45-degree field of view — 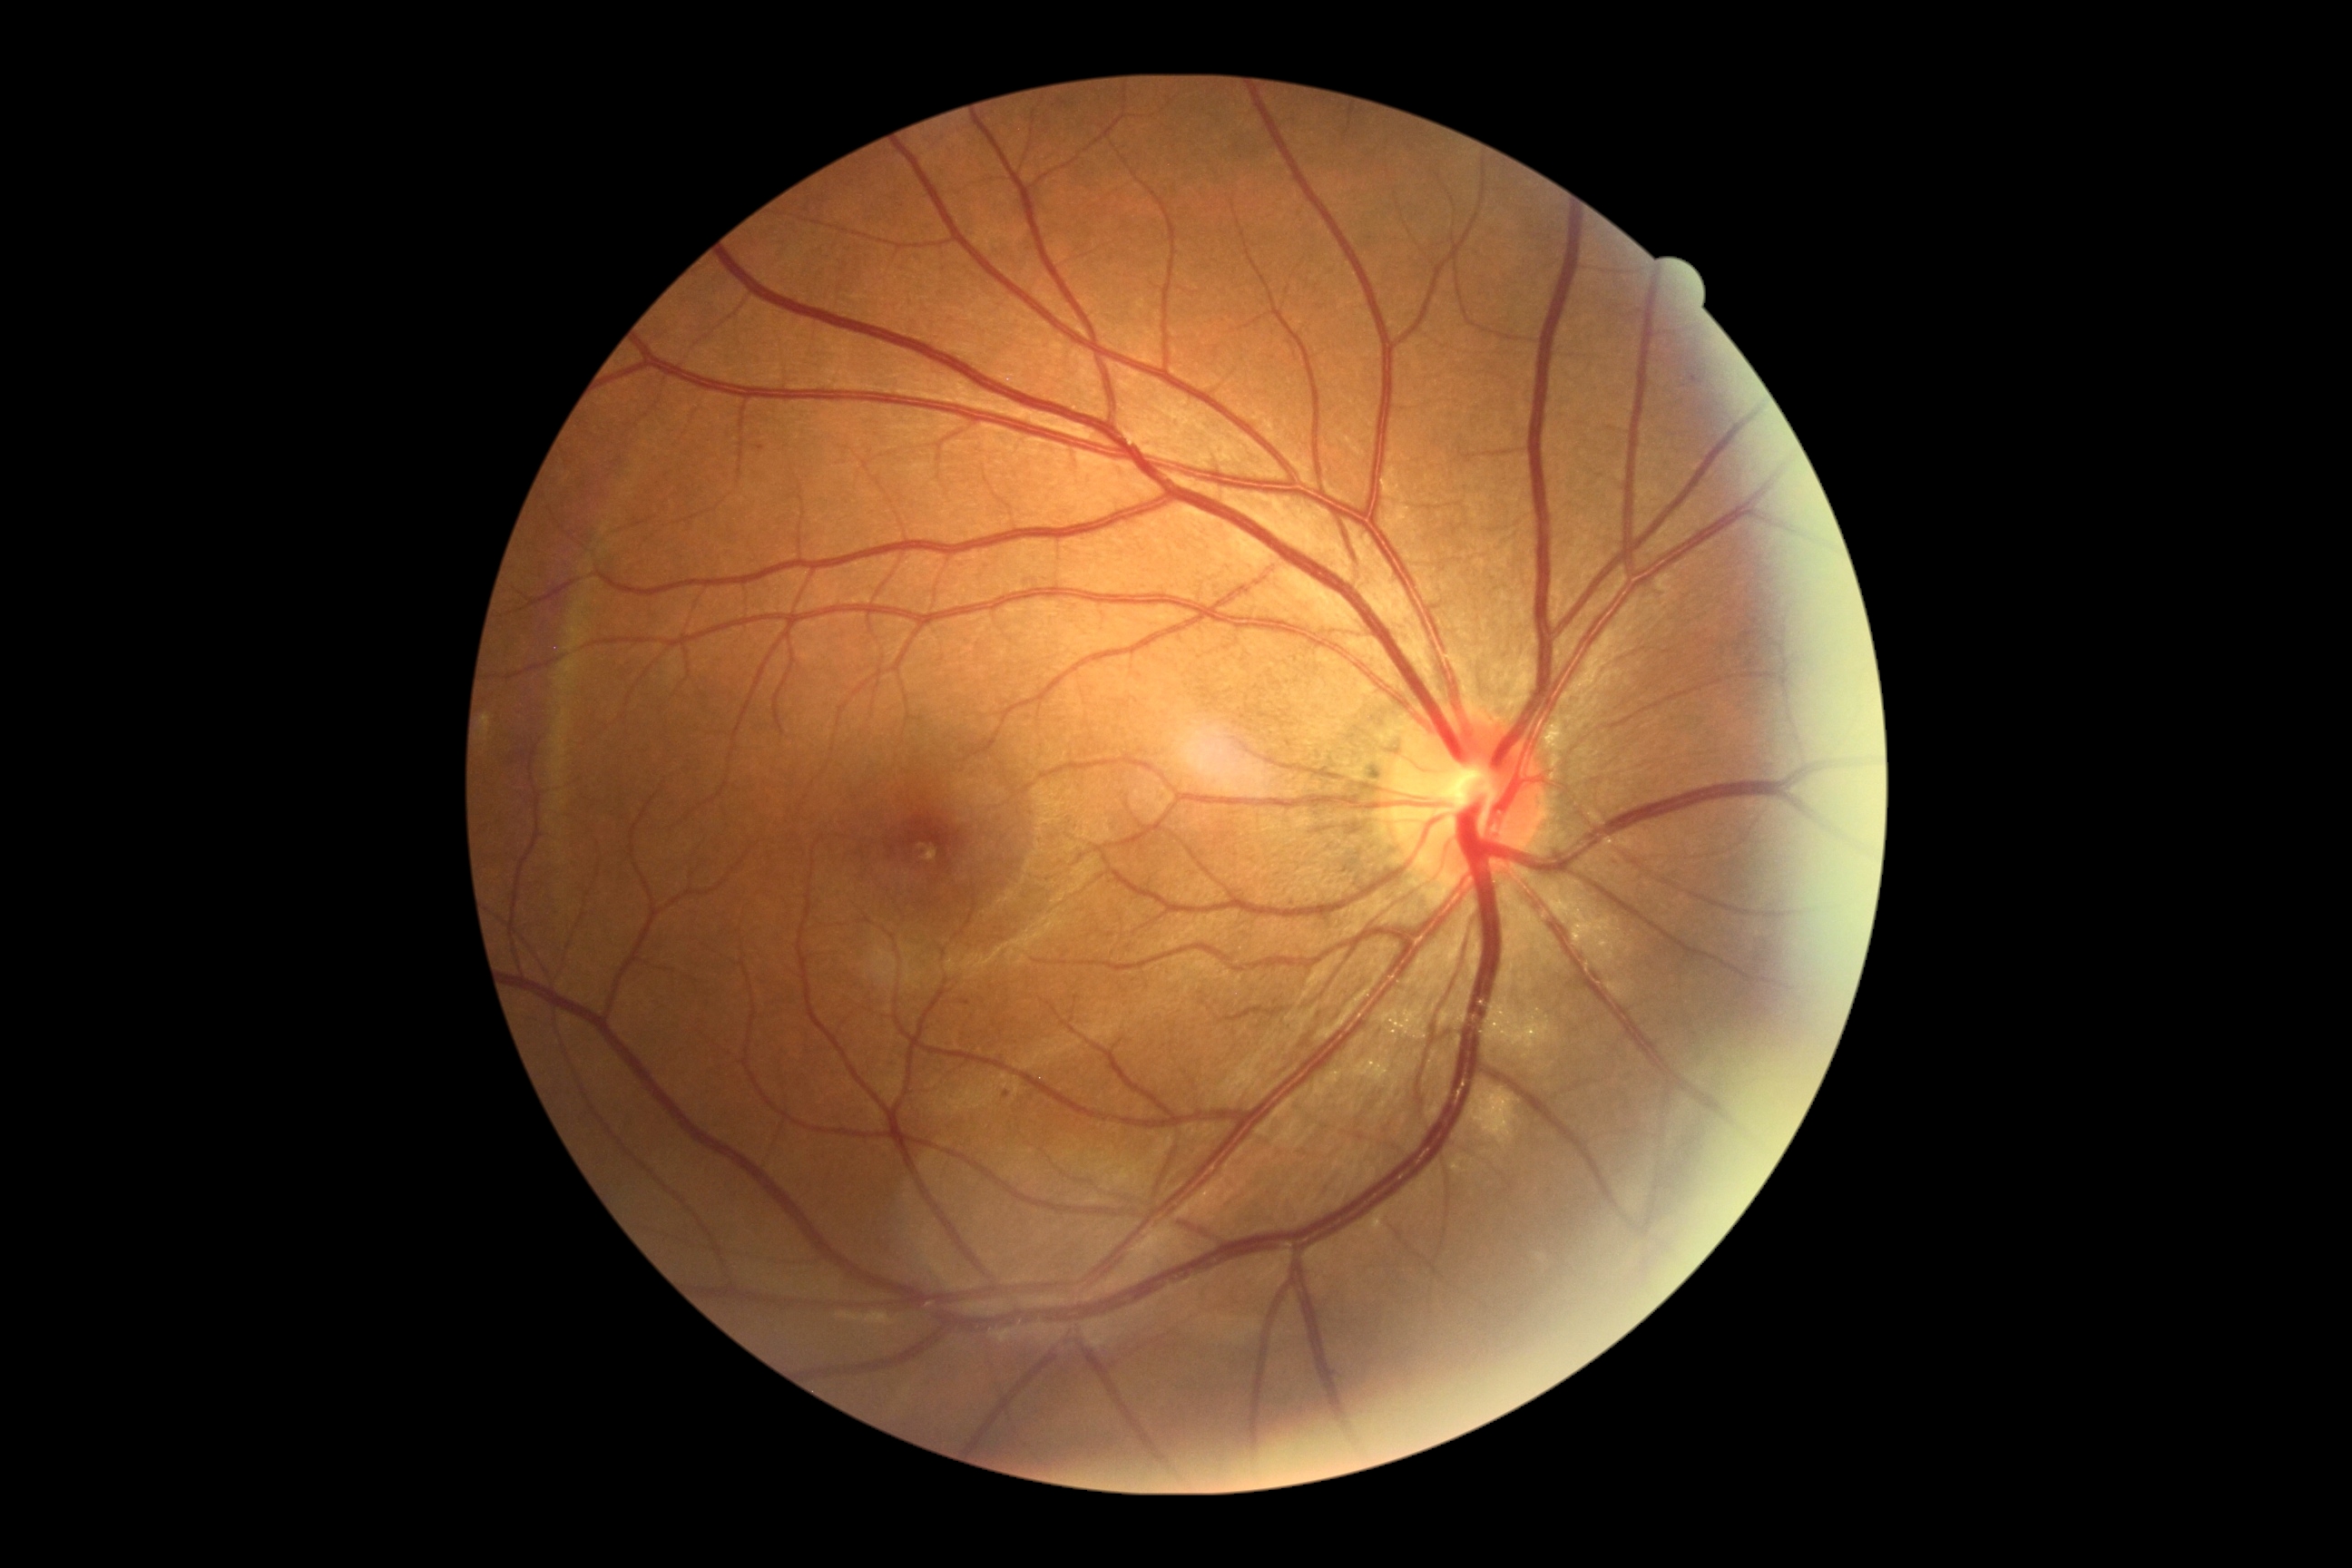
<lesions>
  <dr_grade>1</dr_grade>
  <he />
  <ex />
  <se />
  <ma>1689 375 1703 386</ma>
  <ma_small_approx>(1007; 1094); (761; 448)</ma_small_approx>
</lesions>